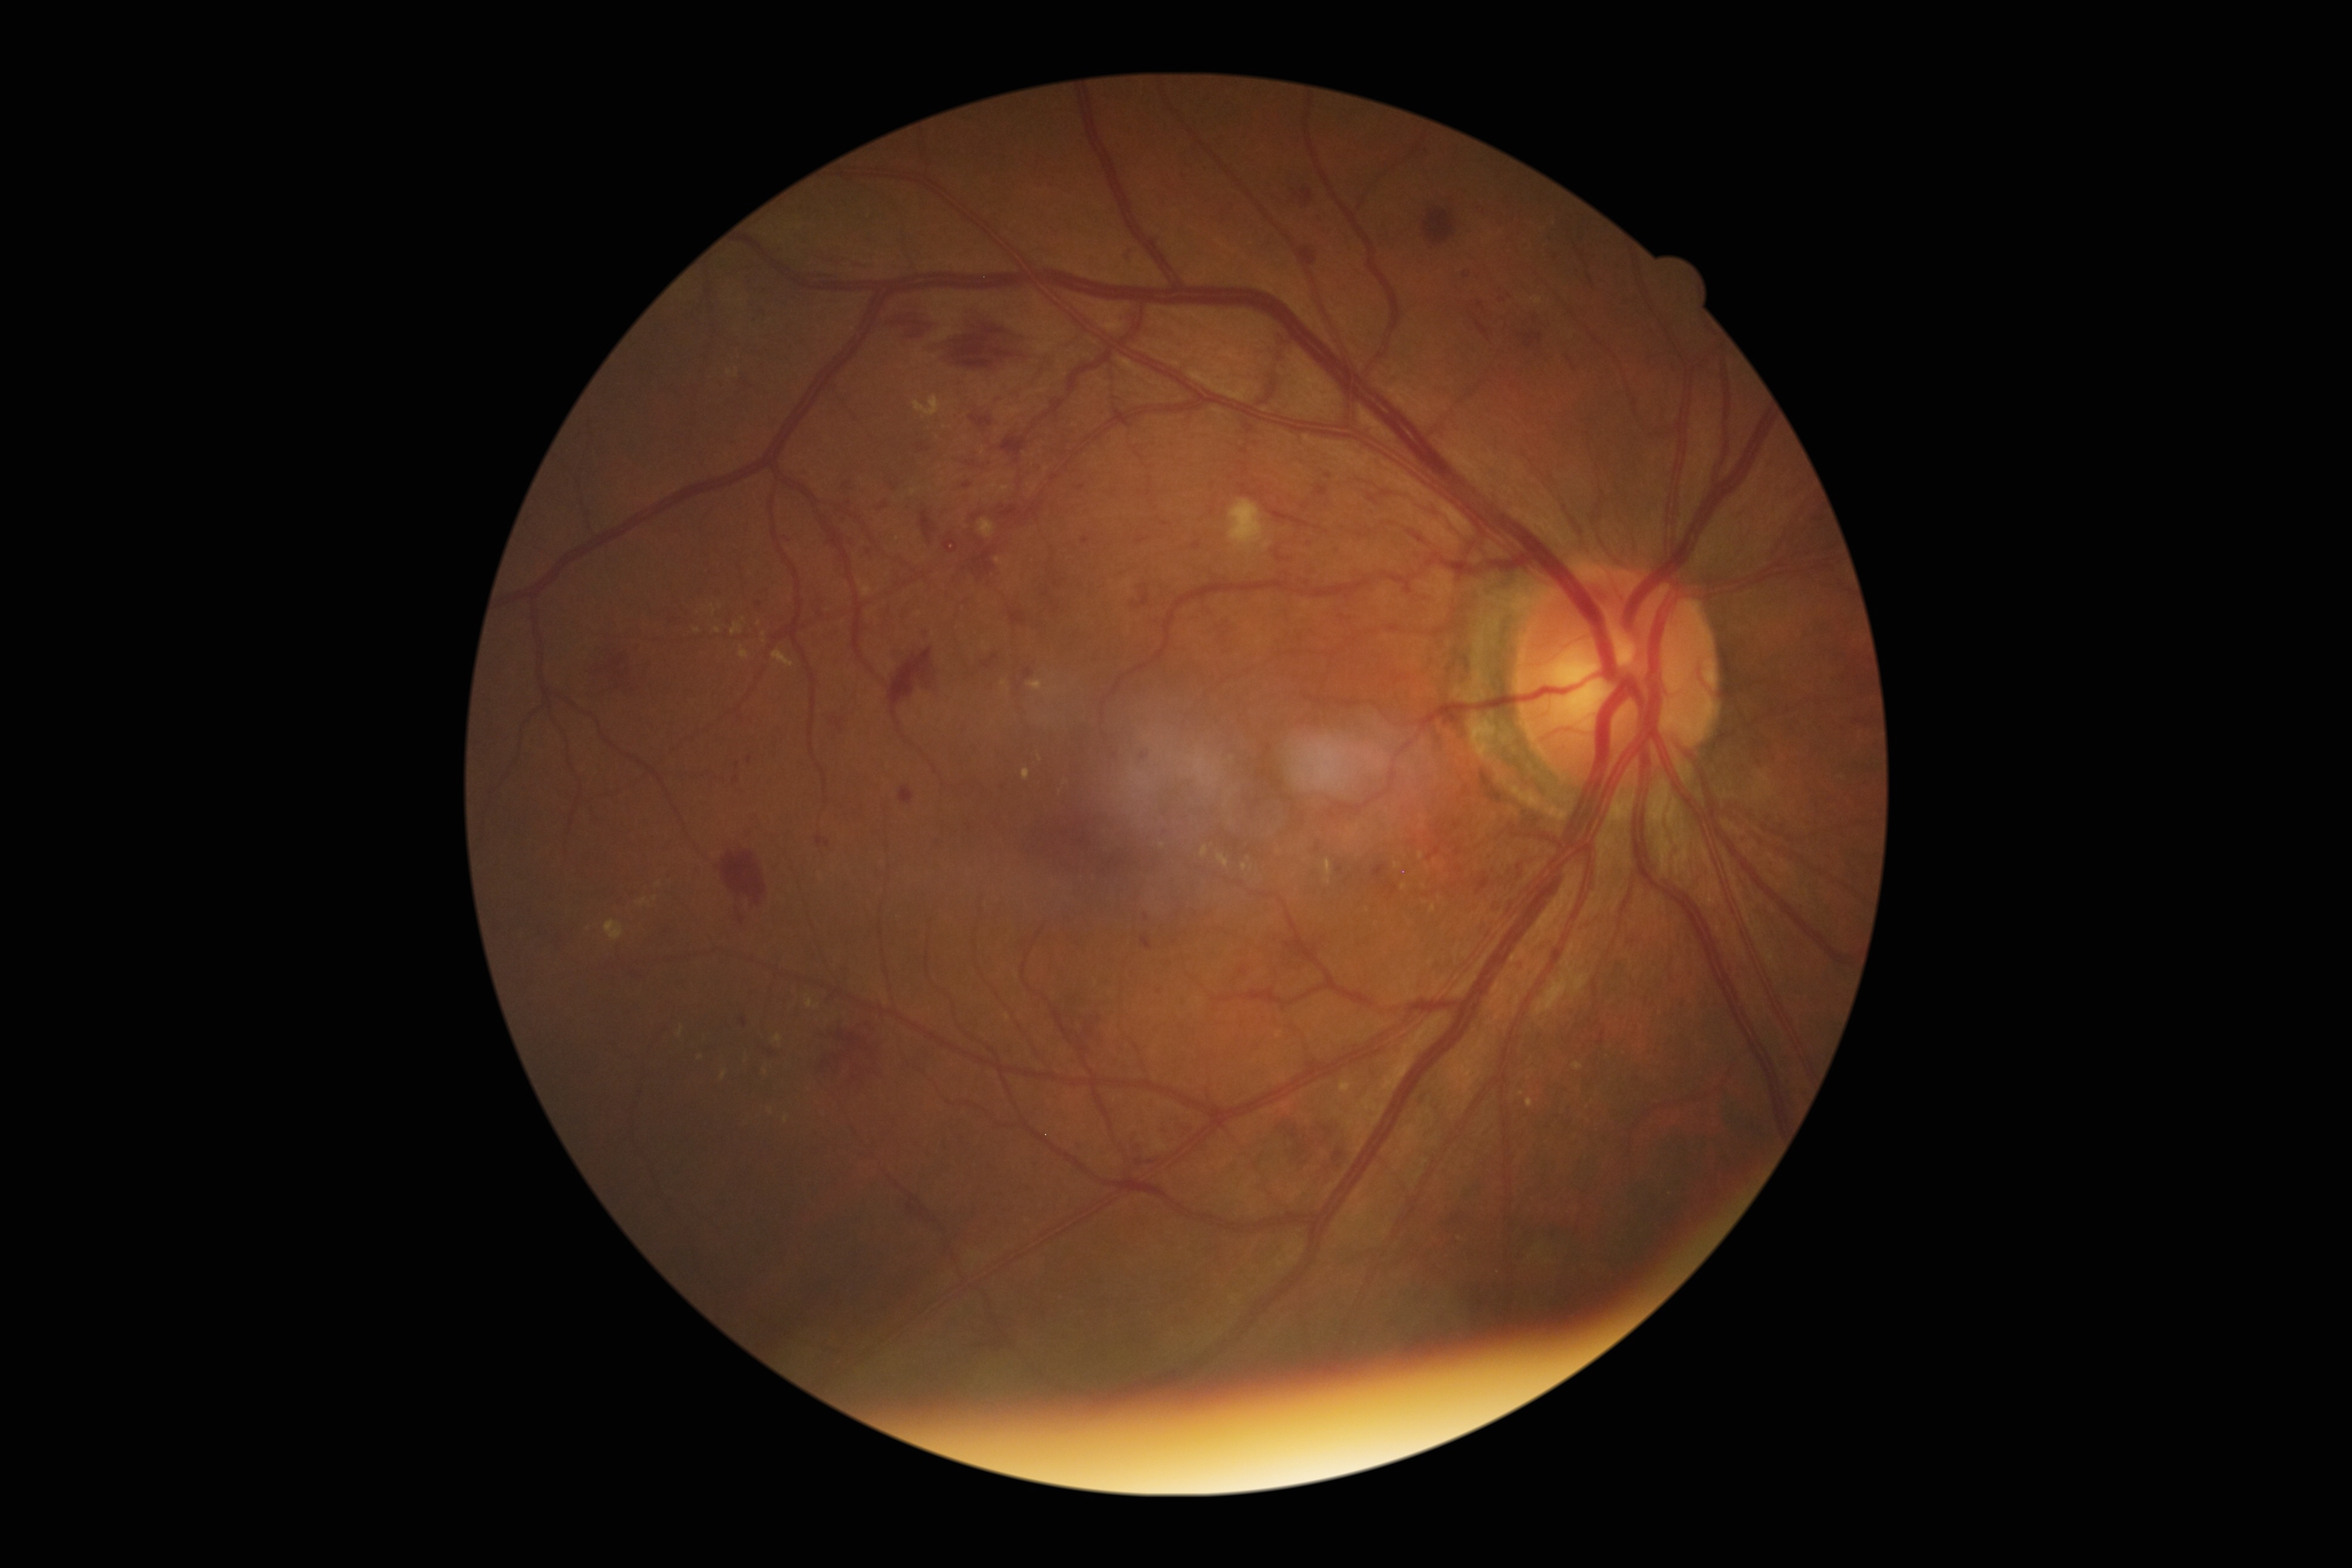 Diabetic retinopathy grade: 2 (moderate NPDR).